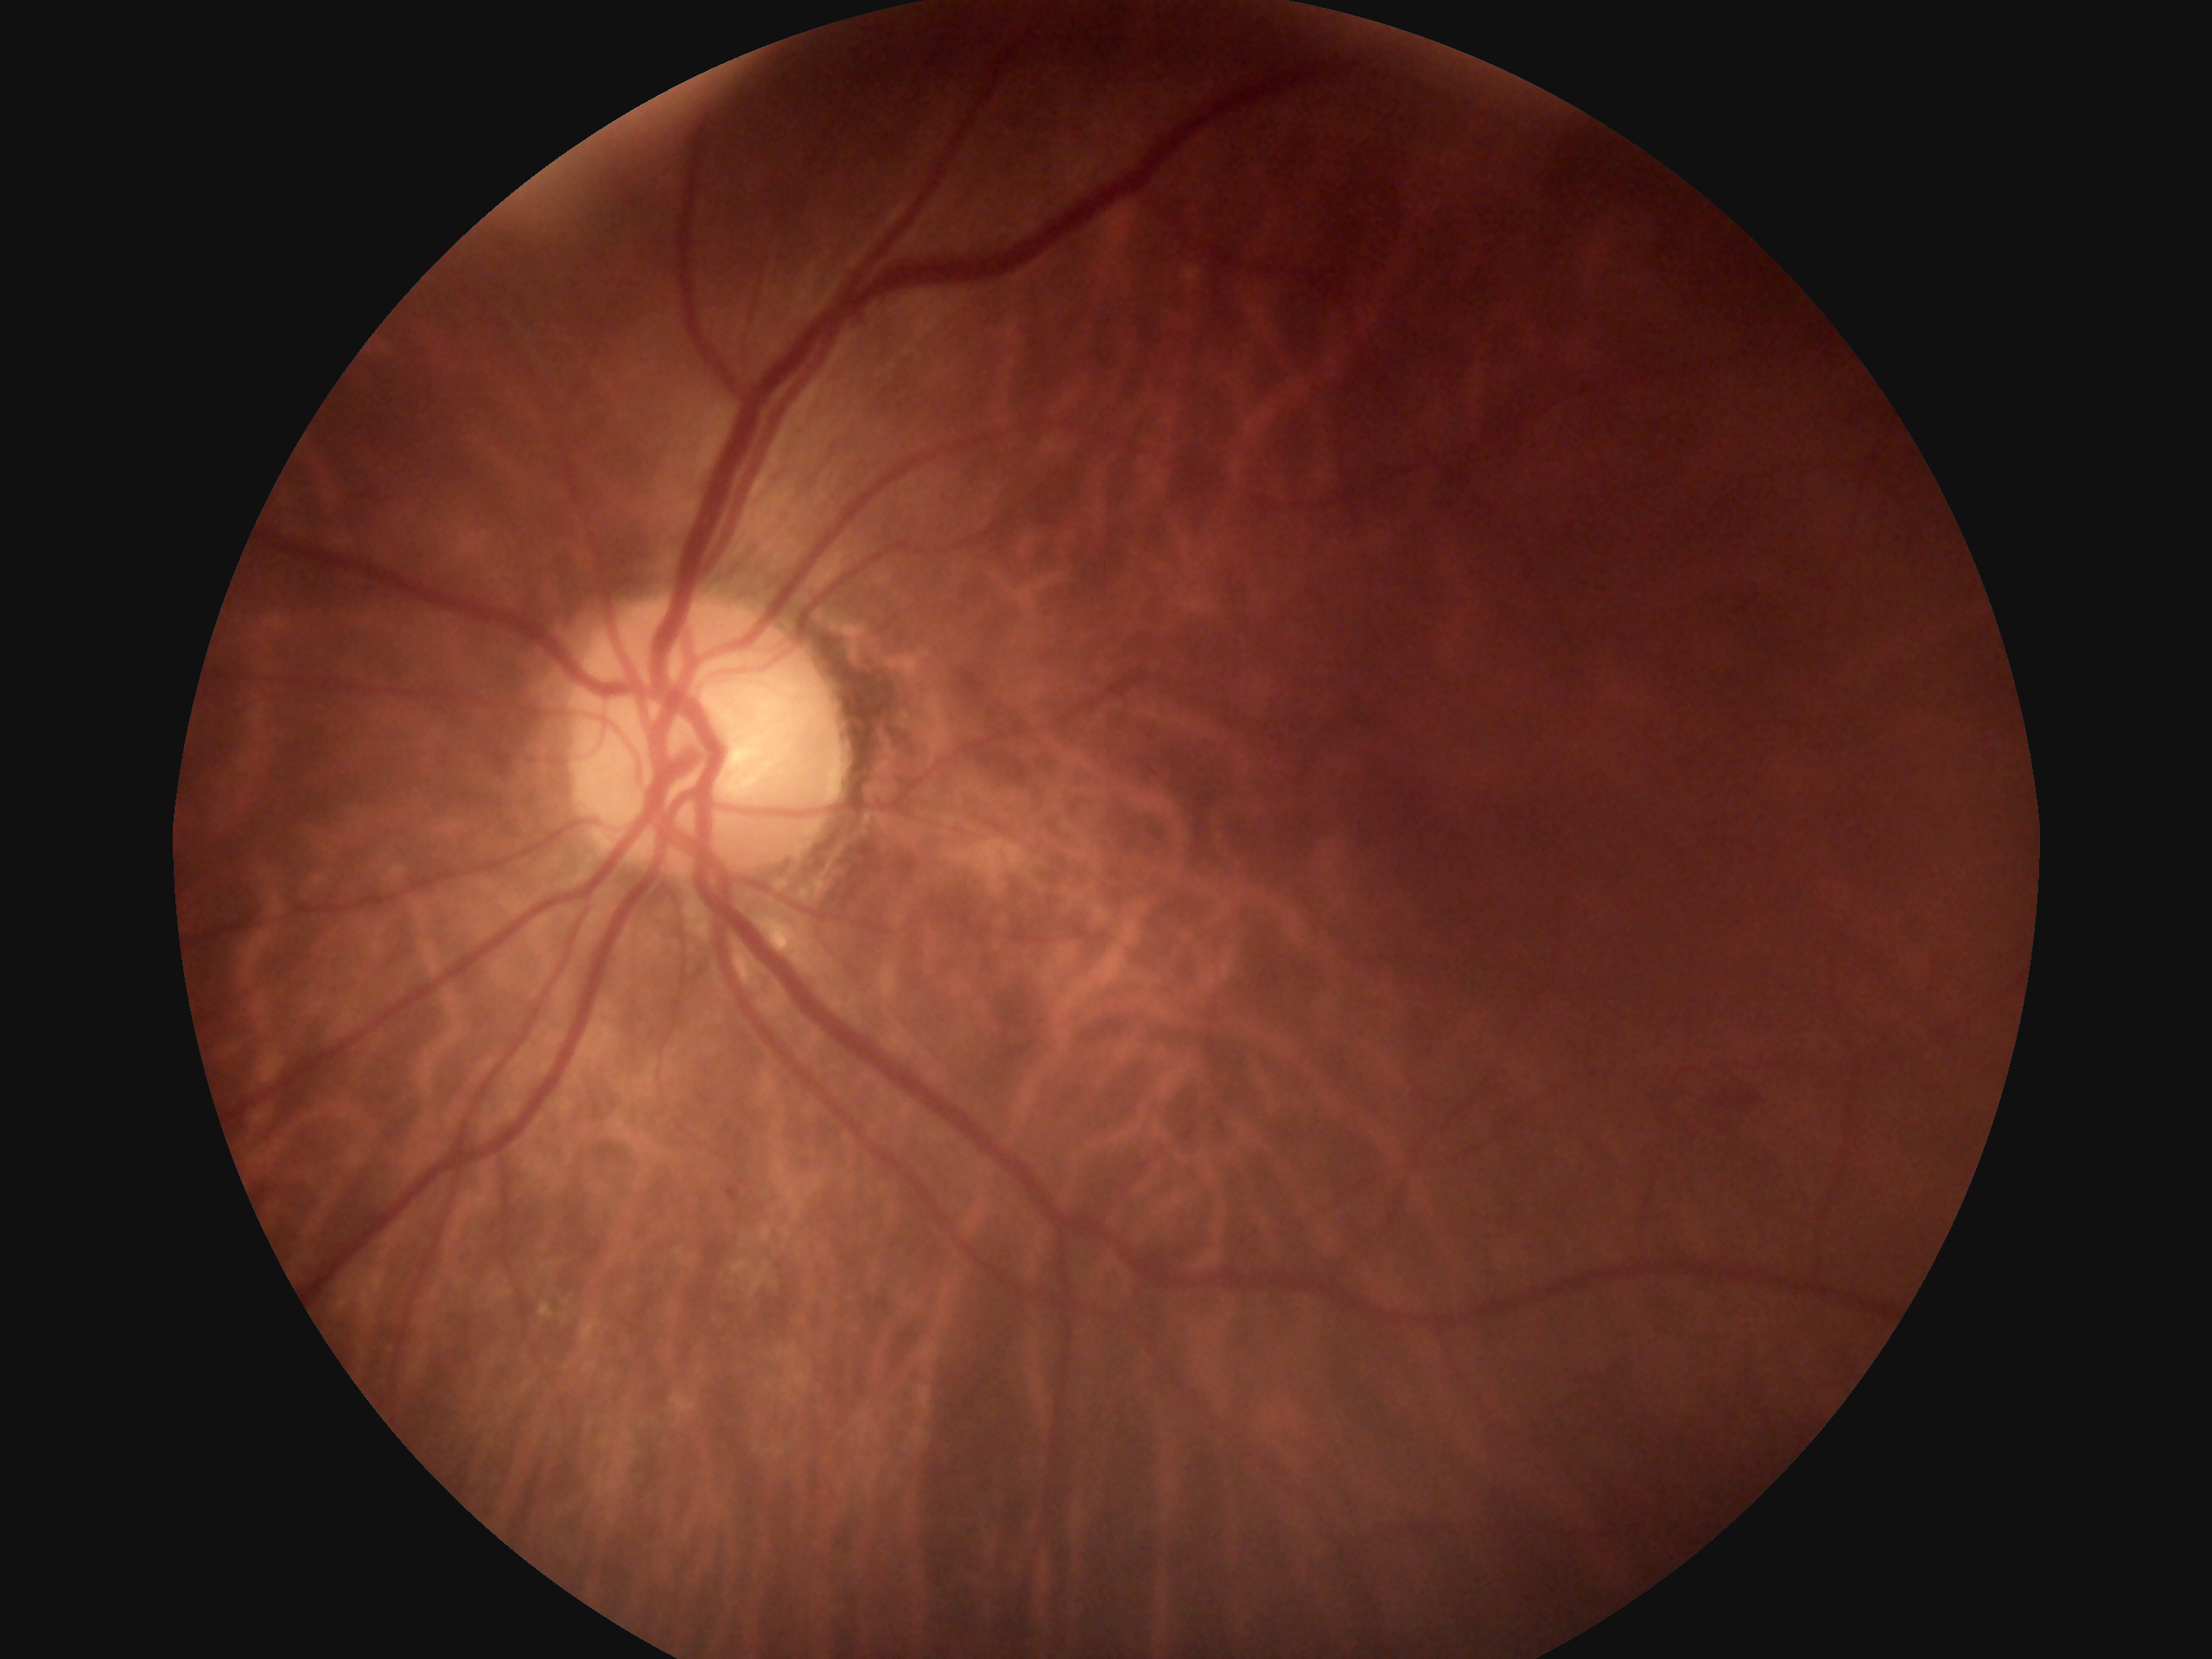
DR = 2/4.